Davis DR grading. Posterior pole photograph
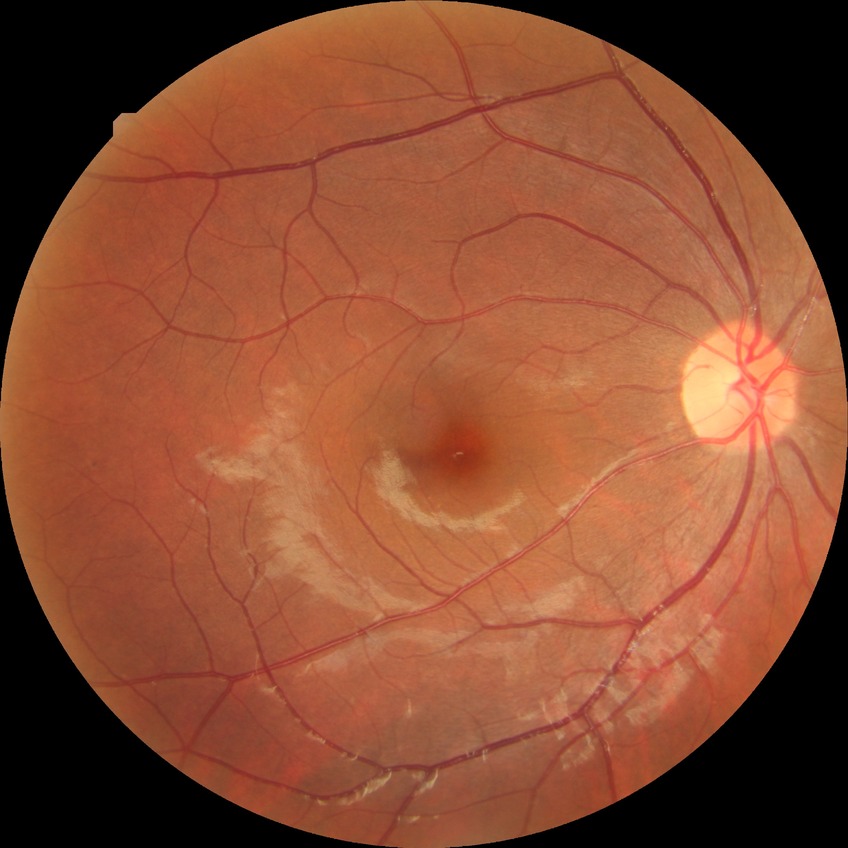

DR is NDR.
No signs of diabetic retinopathy.